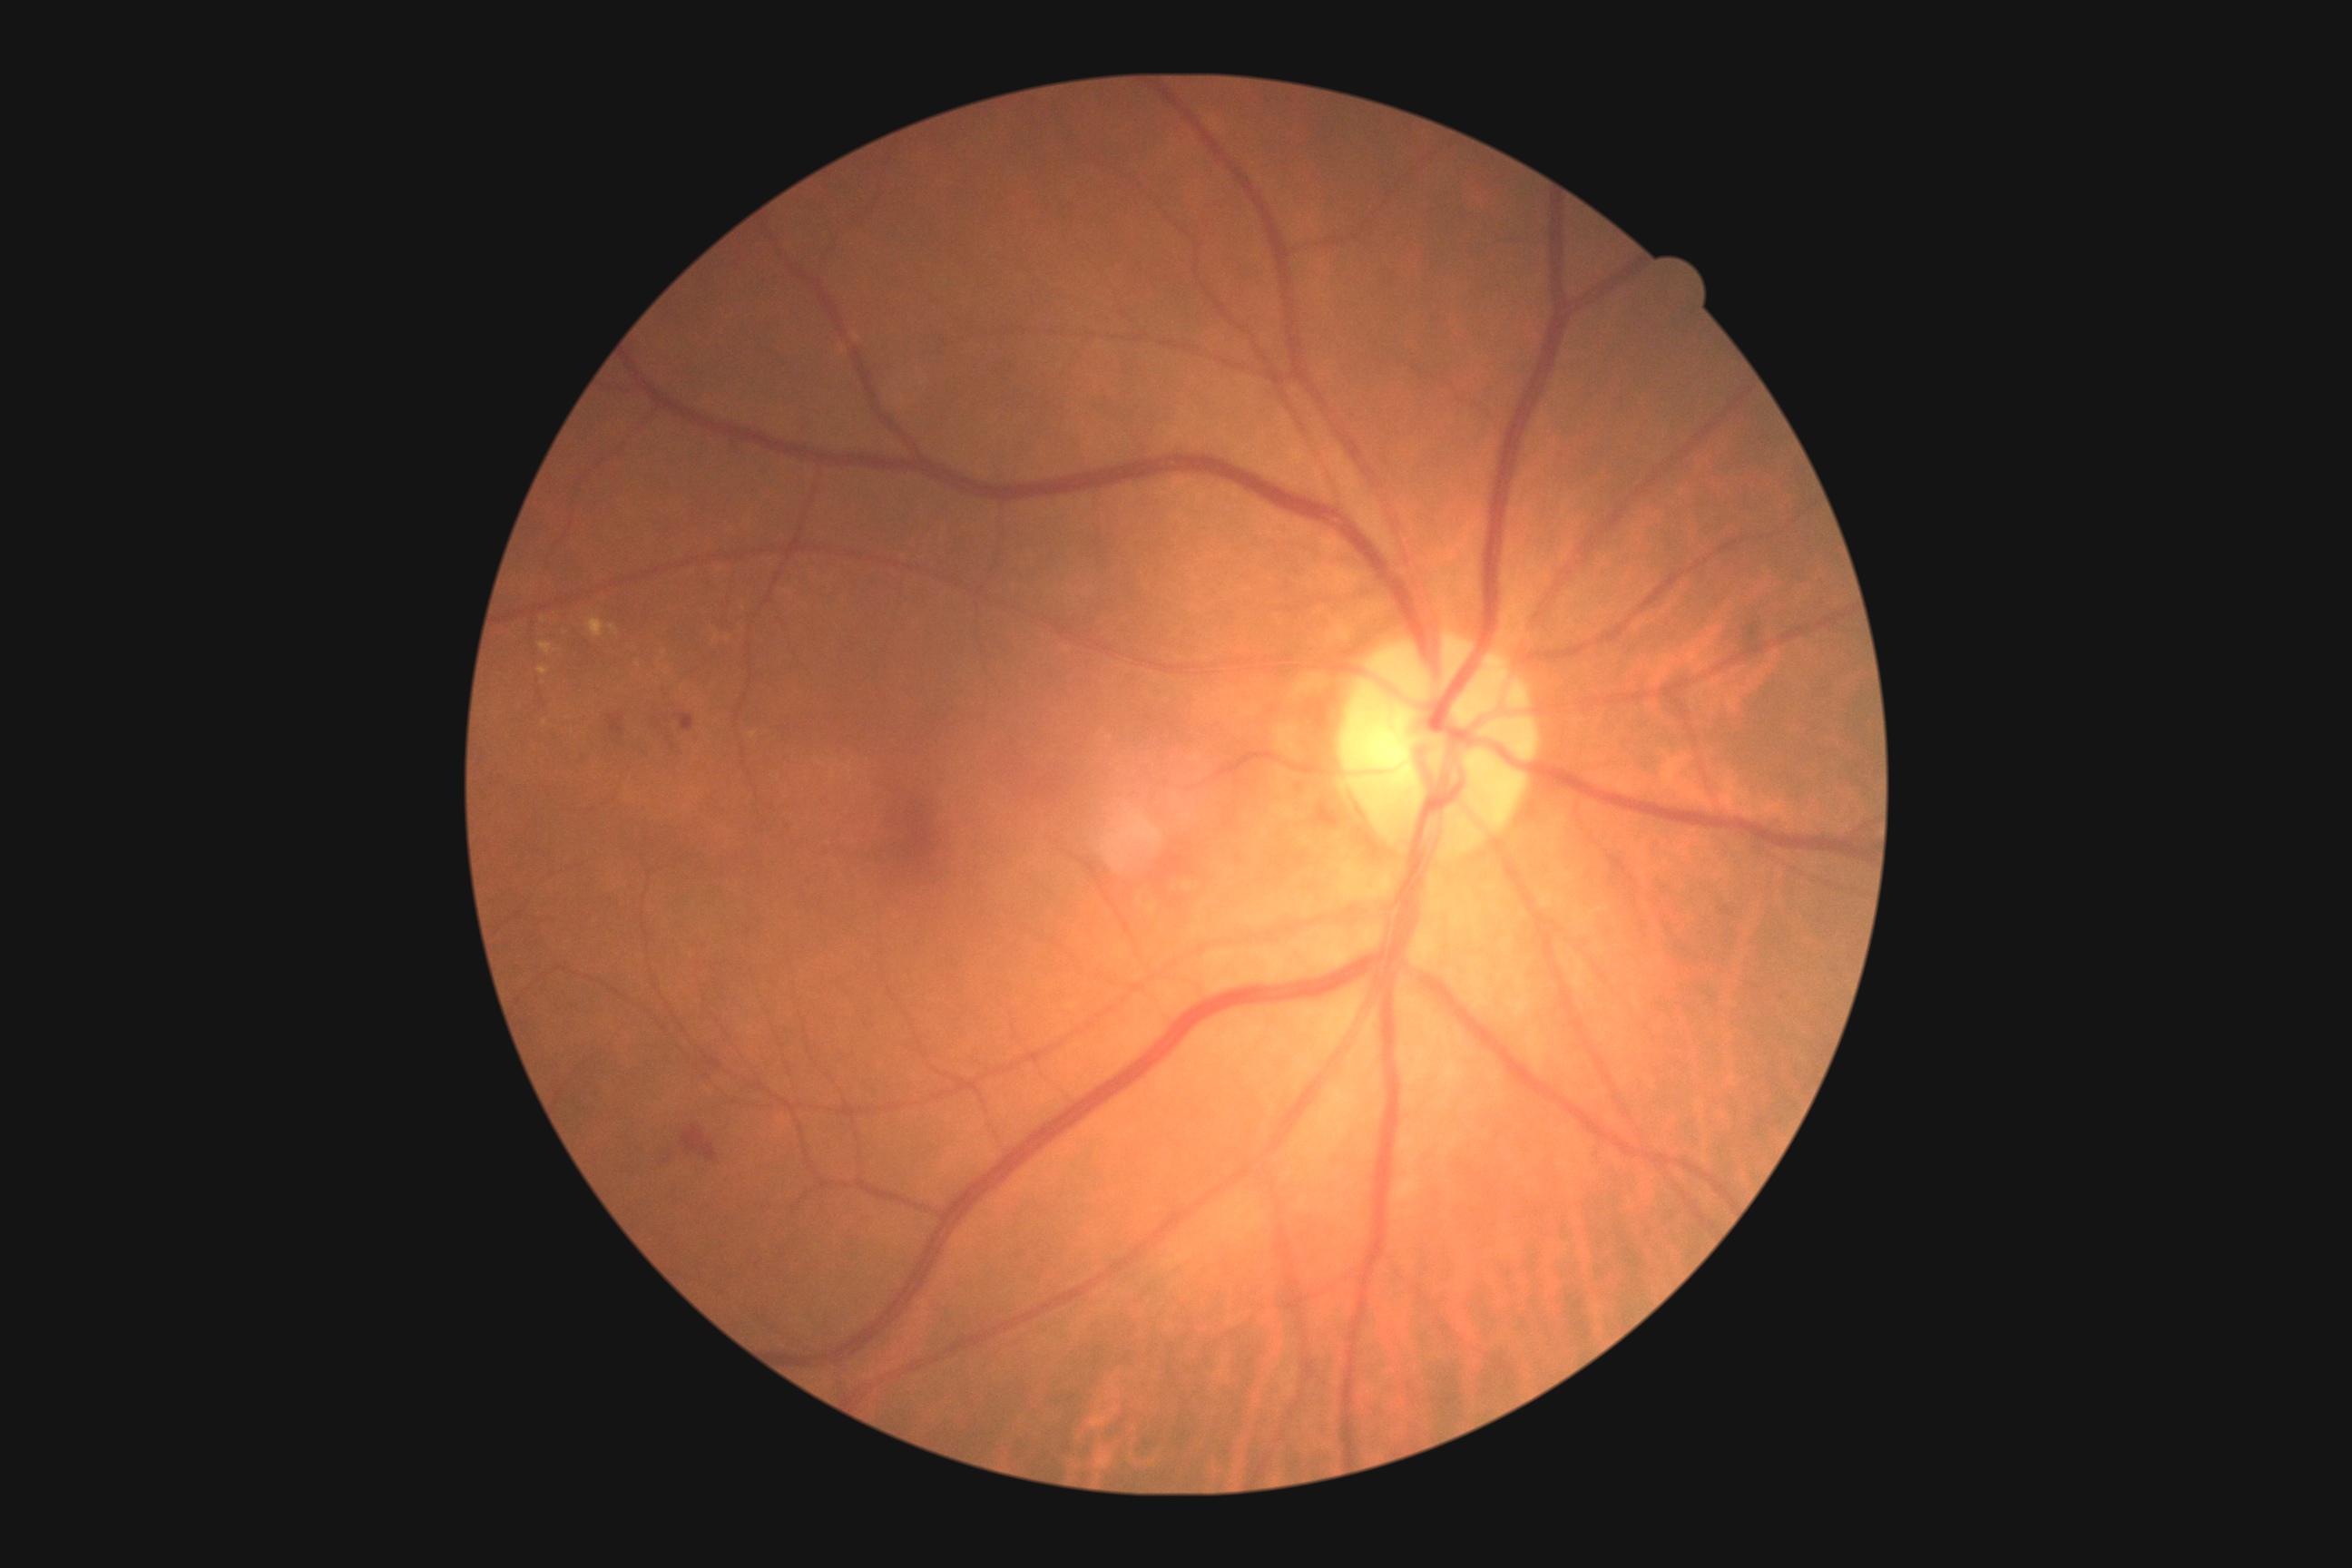 DR stage is grade 2 (moderate NPDR)
A subset of detected lesions:
EXs (partial) = bbox=[540, 643, 553, 654] | bbox=[589, 618, 605, 640] | bbox=[538, 667, 549, 676] | bbox=[609, 625, 618, 636]
Small EXs approximately at [545,723] | [664,653] | [543,620] | [668,671] | [639,664]
MAs (partial) = bbox=[669, 743, 678, 750]
Small MAs approximately at [660,726] | [669,738] | [667,721]
SEs = none
HEs = bbox=[607, 714, 625, 736] | bbox=[676, 714, 696, 732] | bbox=[683, 1124, 718, 1161]